NIDEK AFC-230 · without pupil dilation · 848 by 848 pixels · fundus photo: 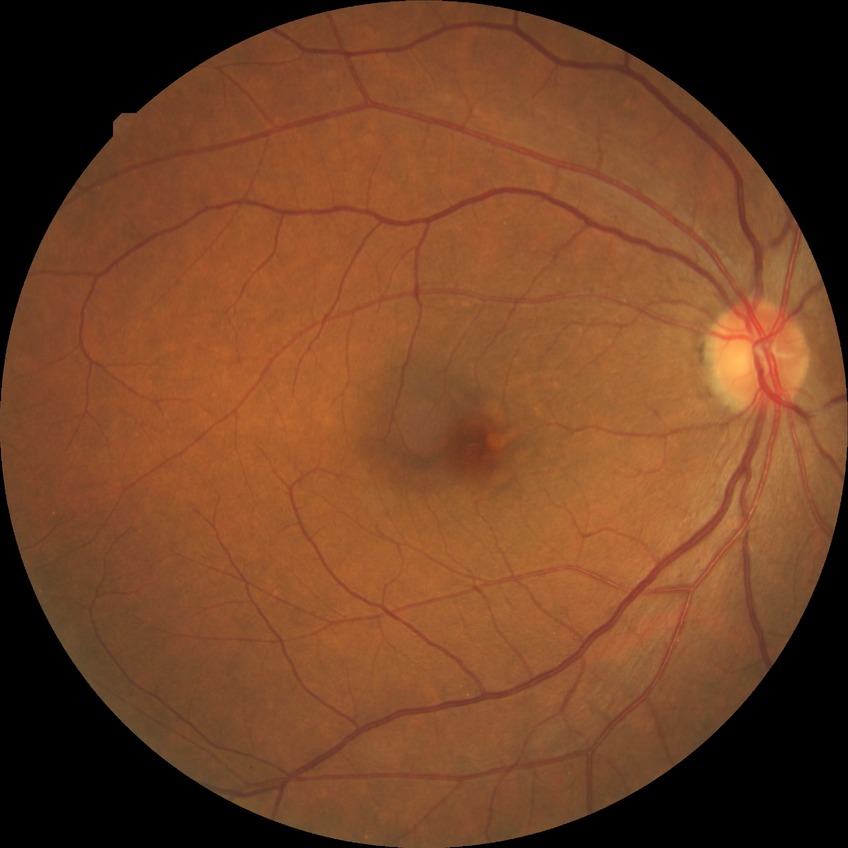

Diabetic retinopathy (DR): SDR (simple diabetic retinopathy). Disease class: non-proliferative diabetic retinopathy.